45-degree field of view: 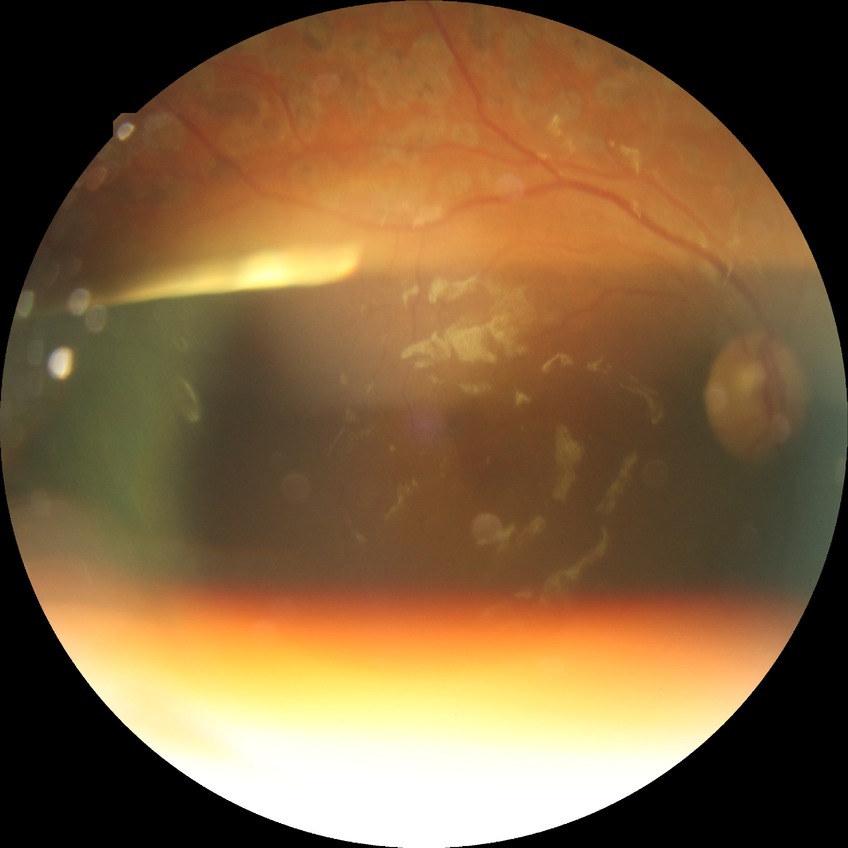

Retinopathy grade: proliferative diabetic retinopathy.